848 by 848 pixels, nonmydriatic fundus photograph, CFP, NIDEK AFC-230:
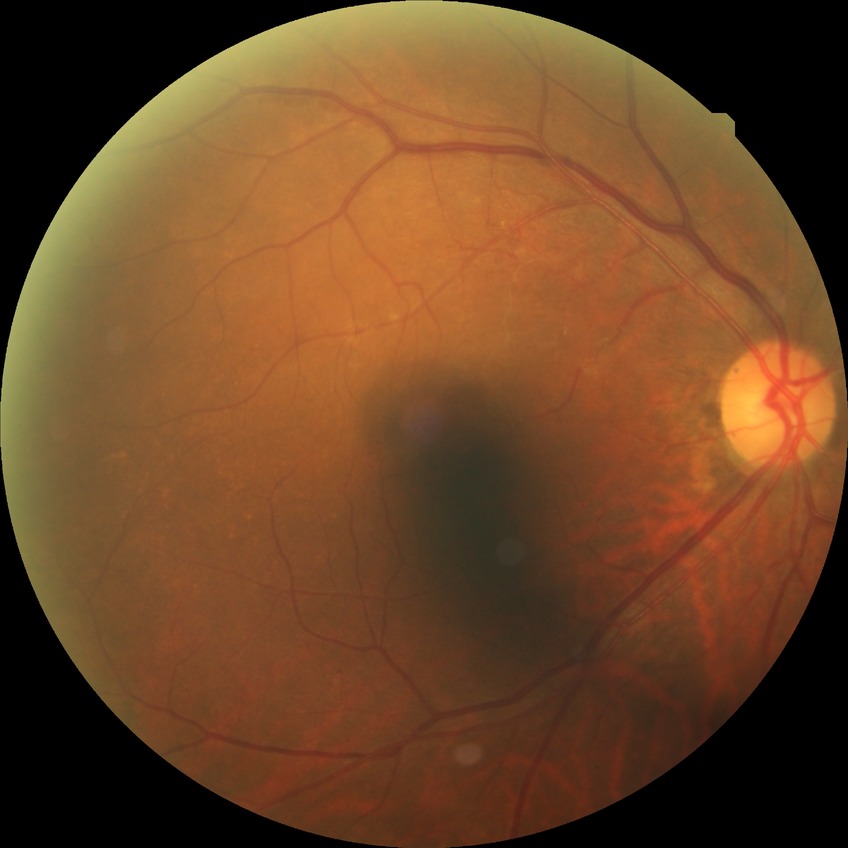

diabetic retinopathy (DR): NDR (no diabetic retinopathy).